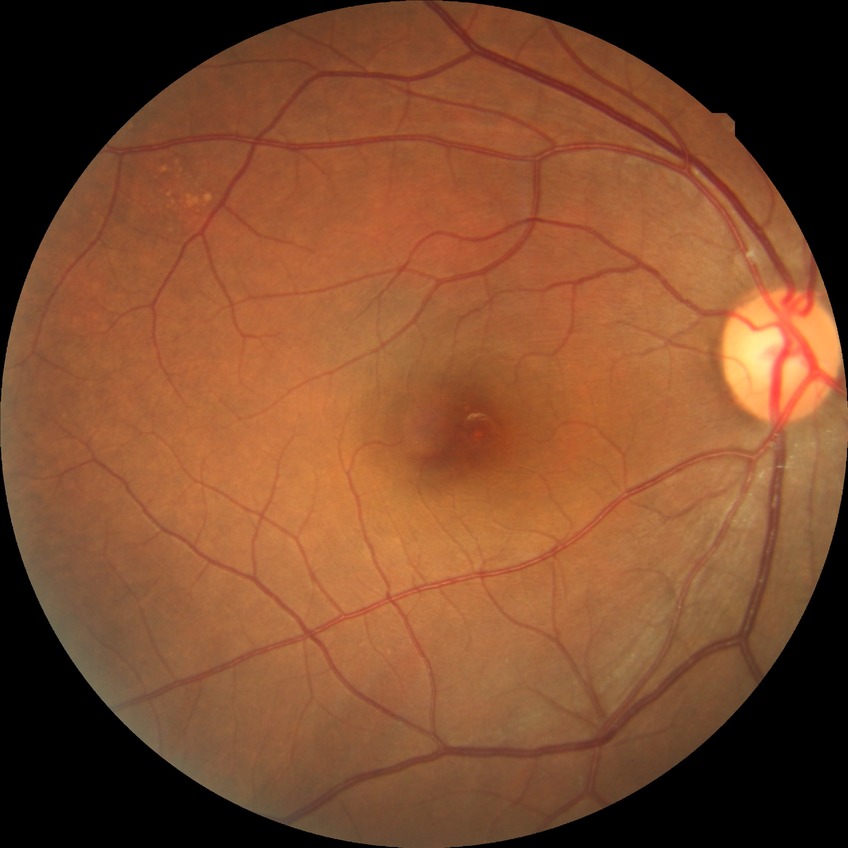 modified Davis classification: no diabetic retinopathy.